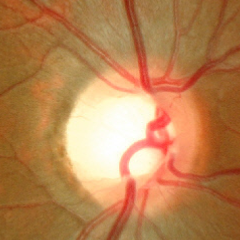
This fundus photograph shows no glaucomatous optic neuropathy.